45° field of view · NIDEK AFC-230 · Davis DR grading:
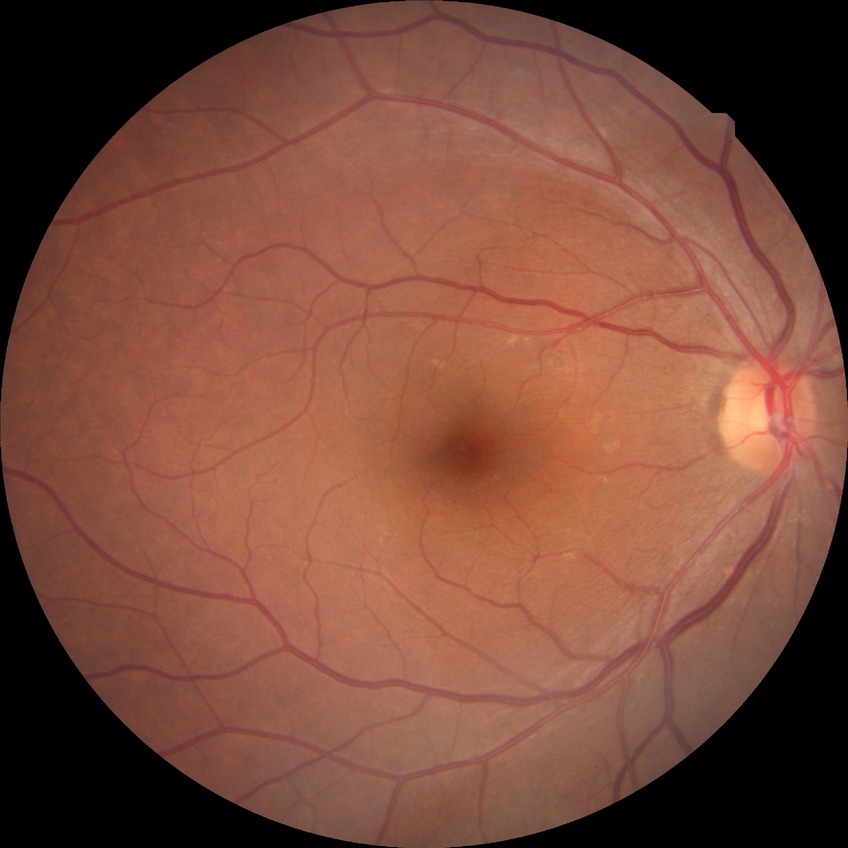 Davis stage: NDR.